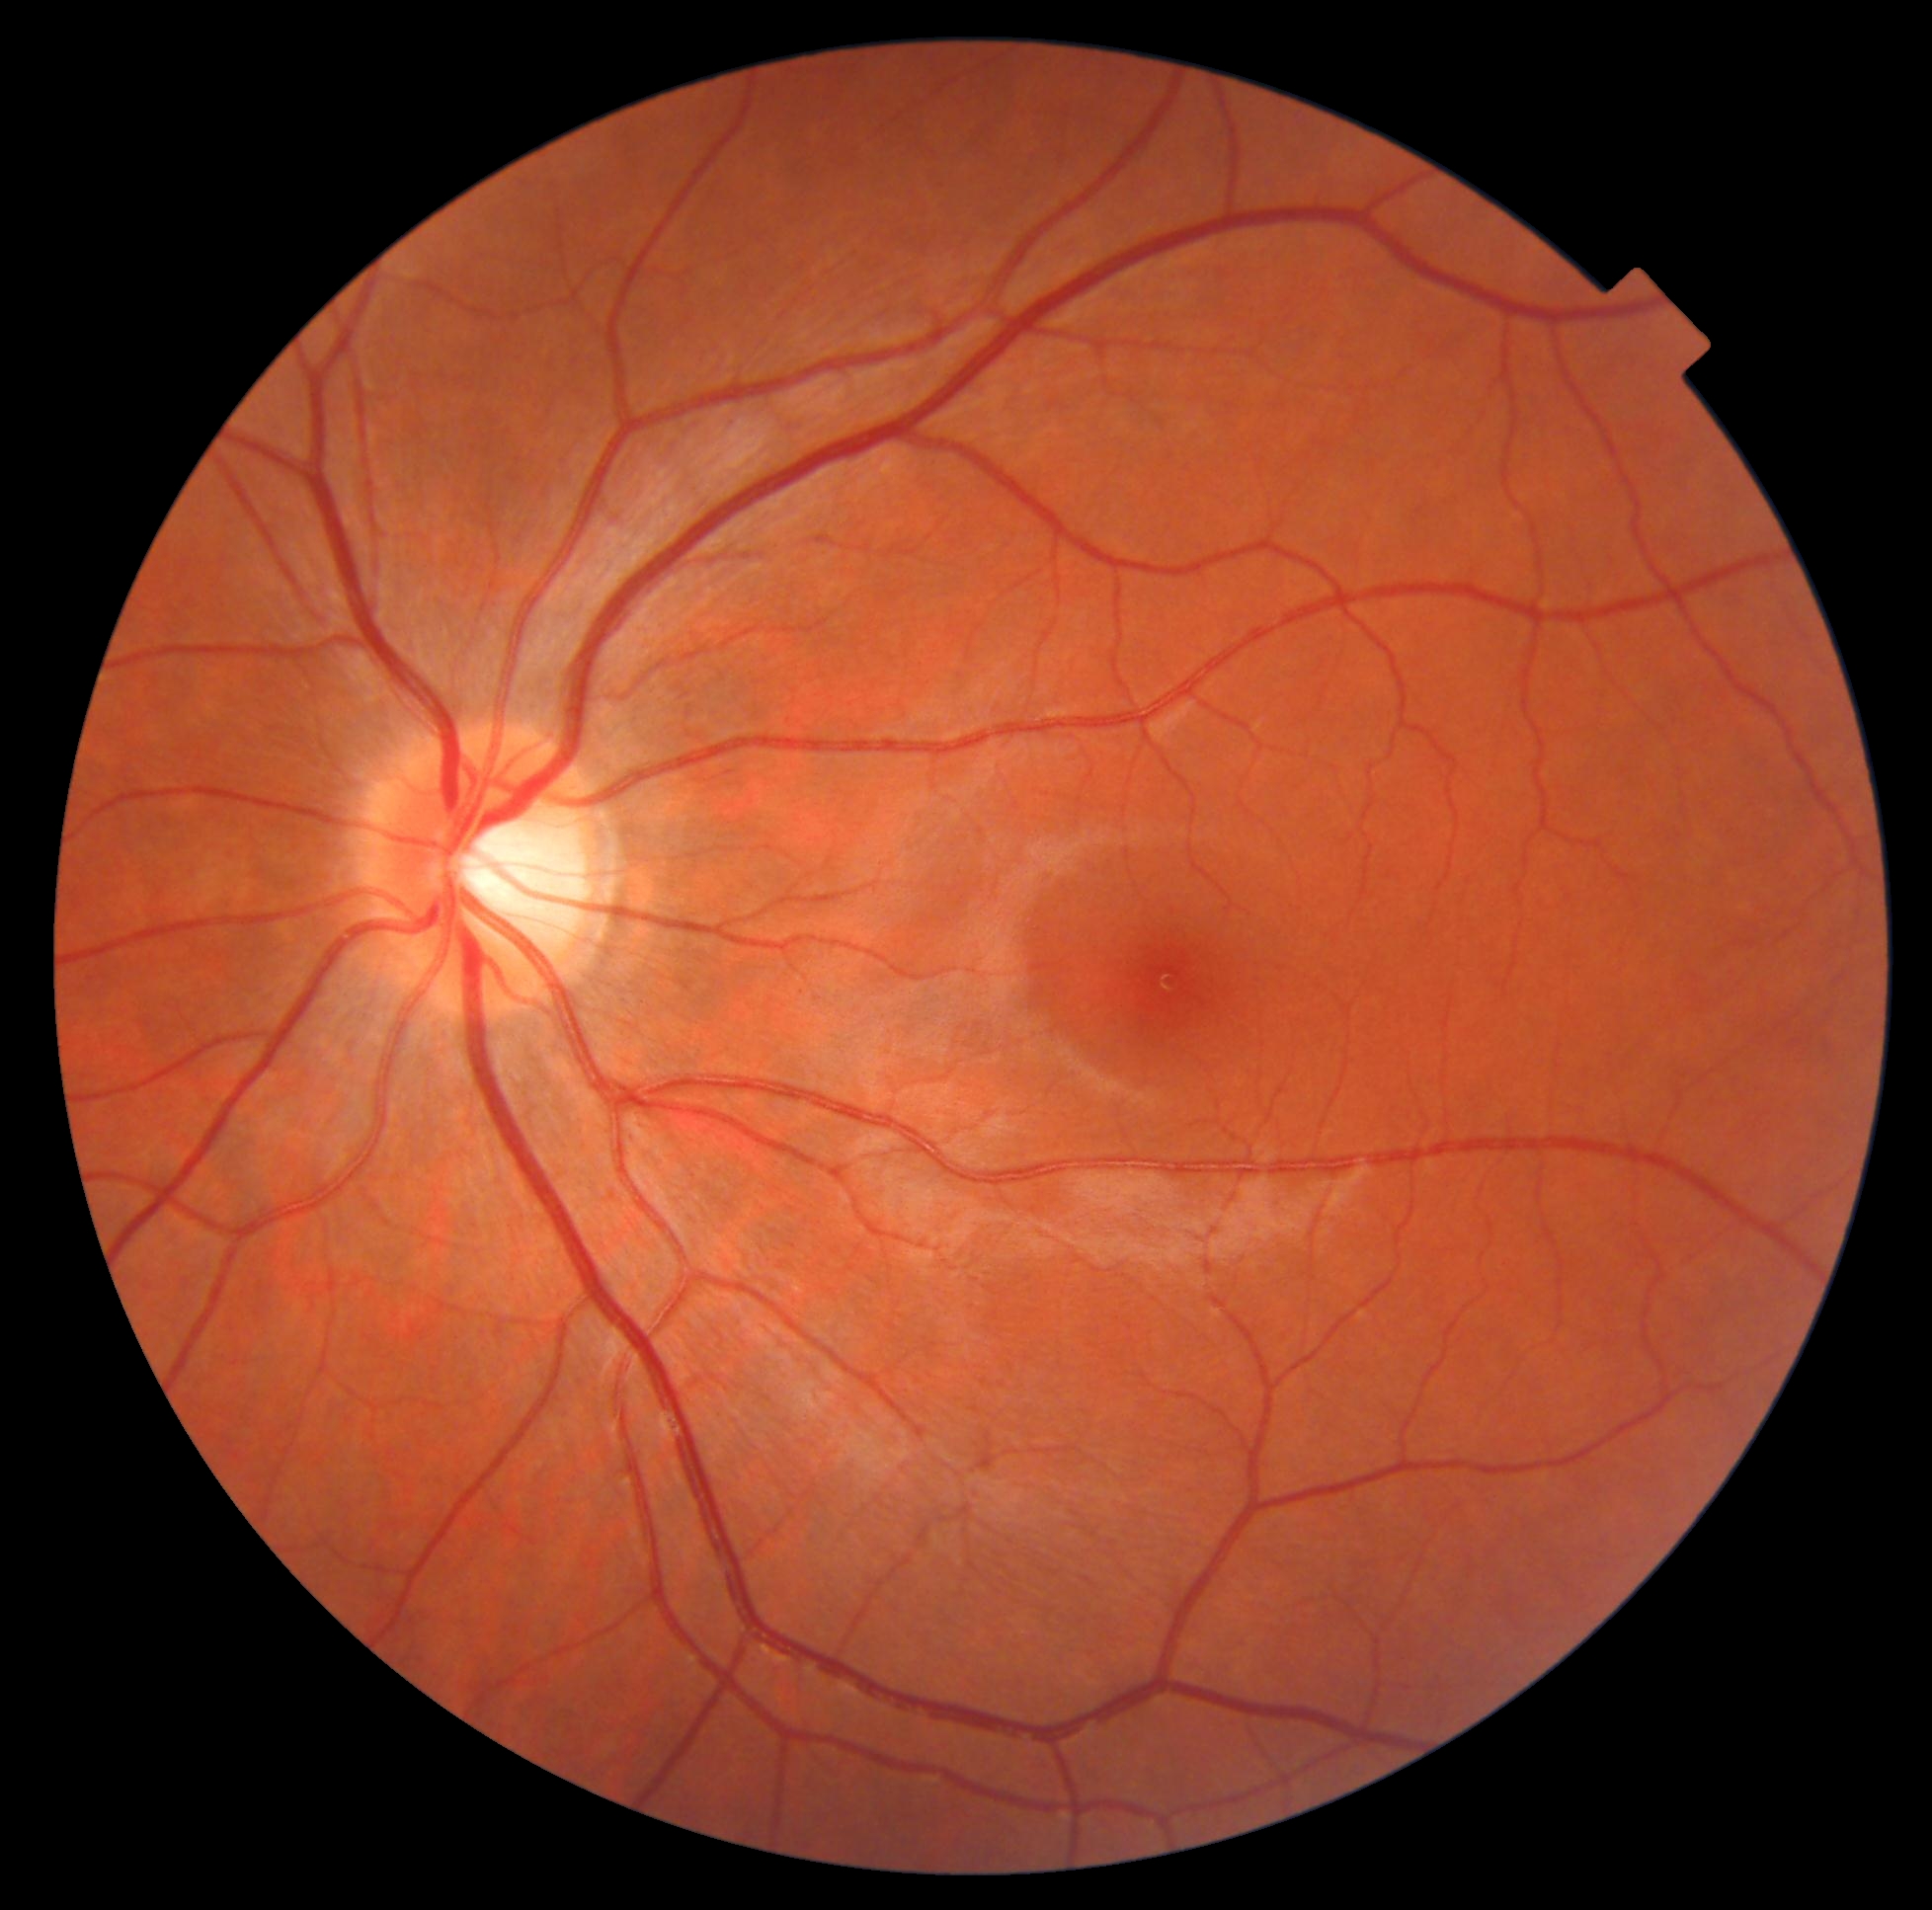 Diabetic retinopathy grade: 0/4. No diabetic retinal disease findings.